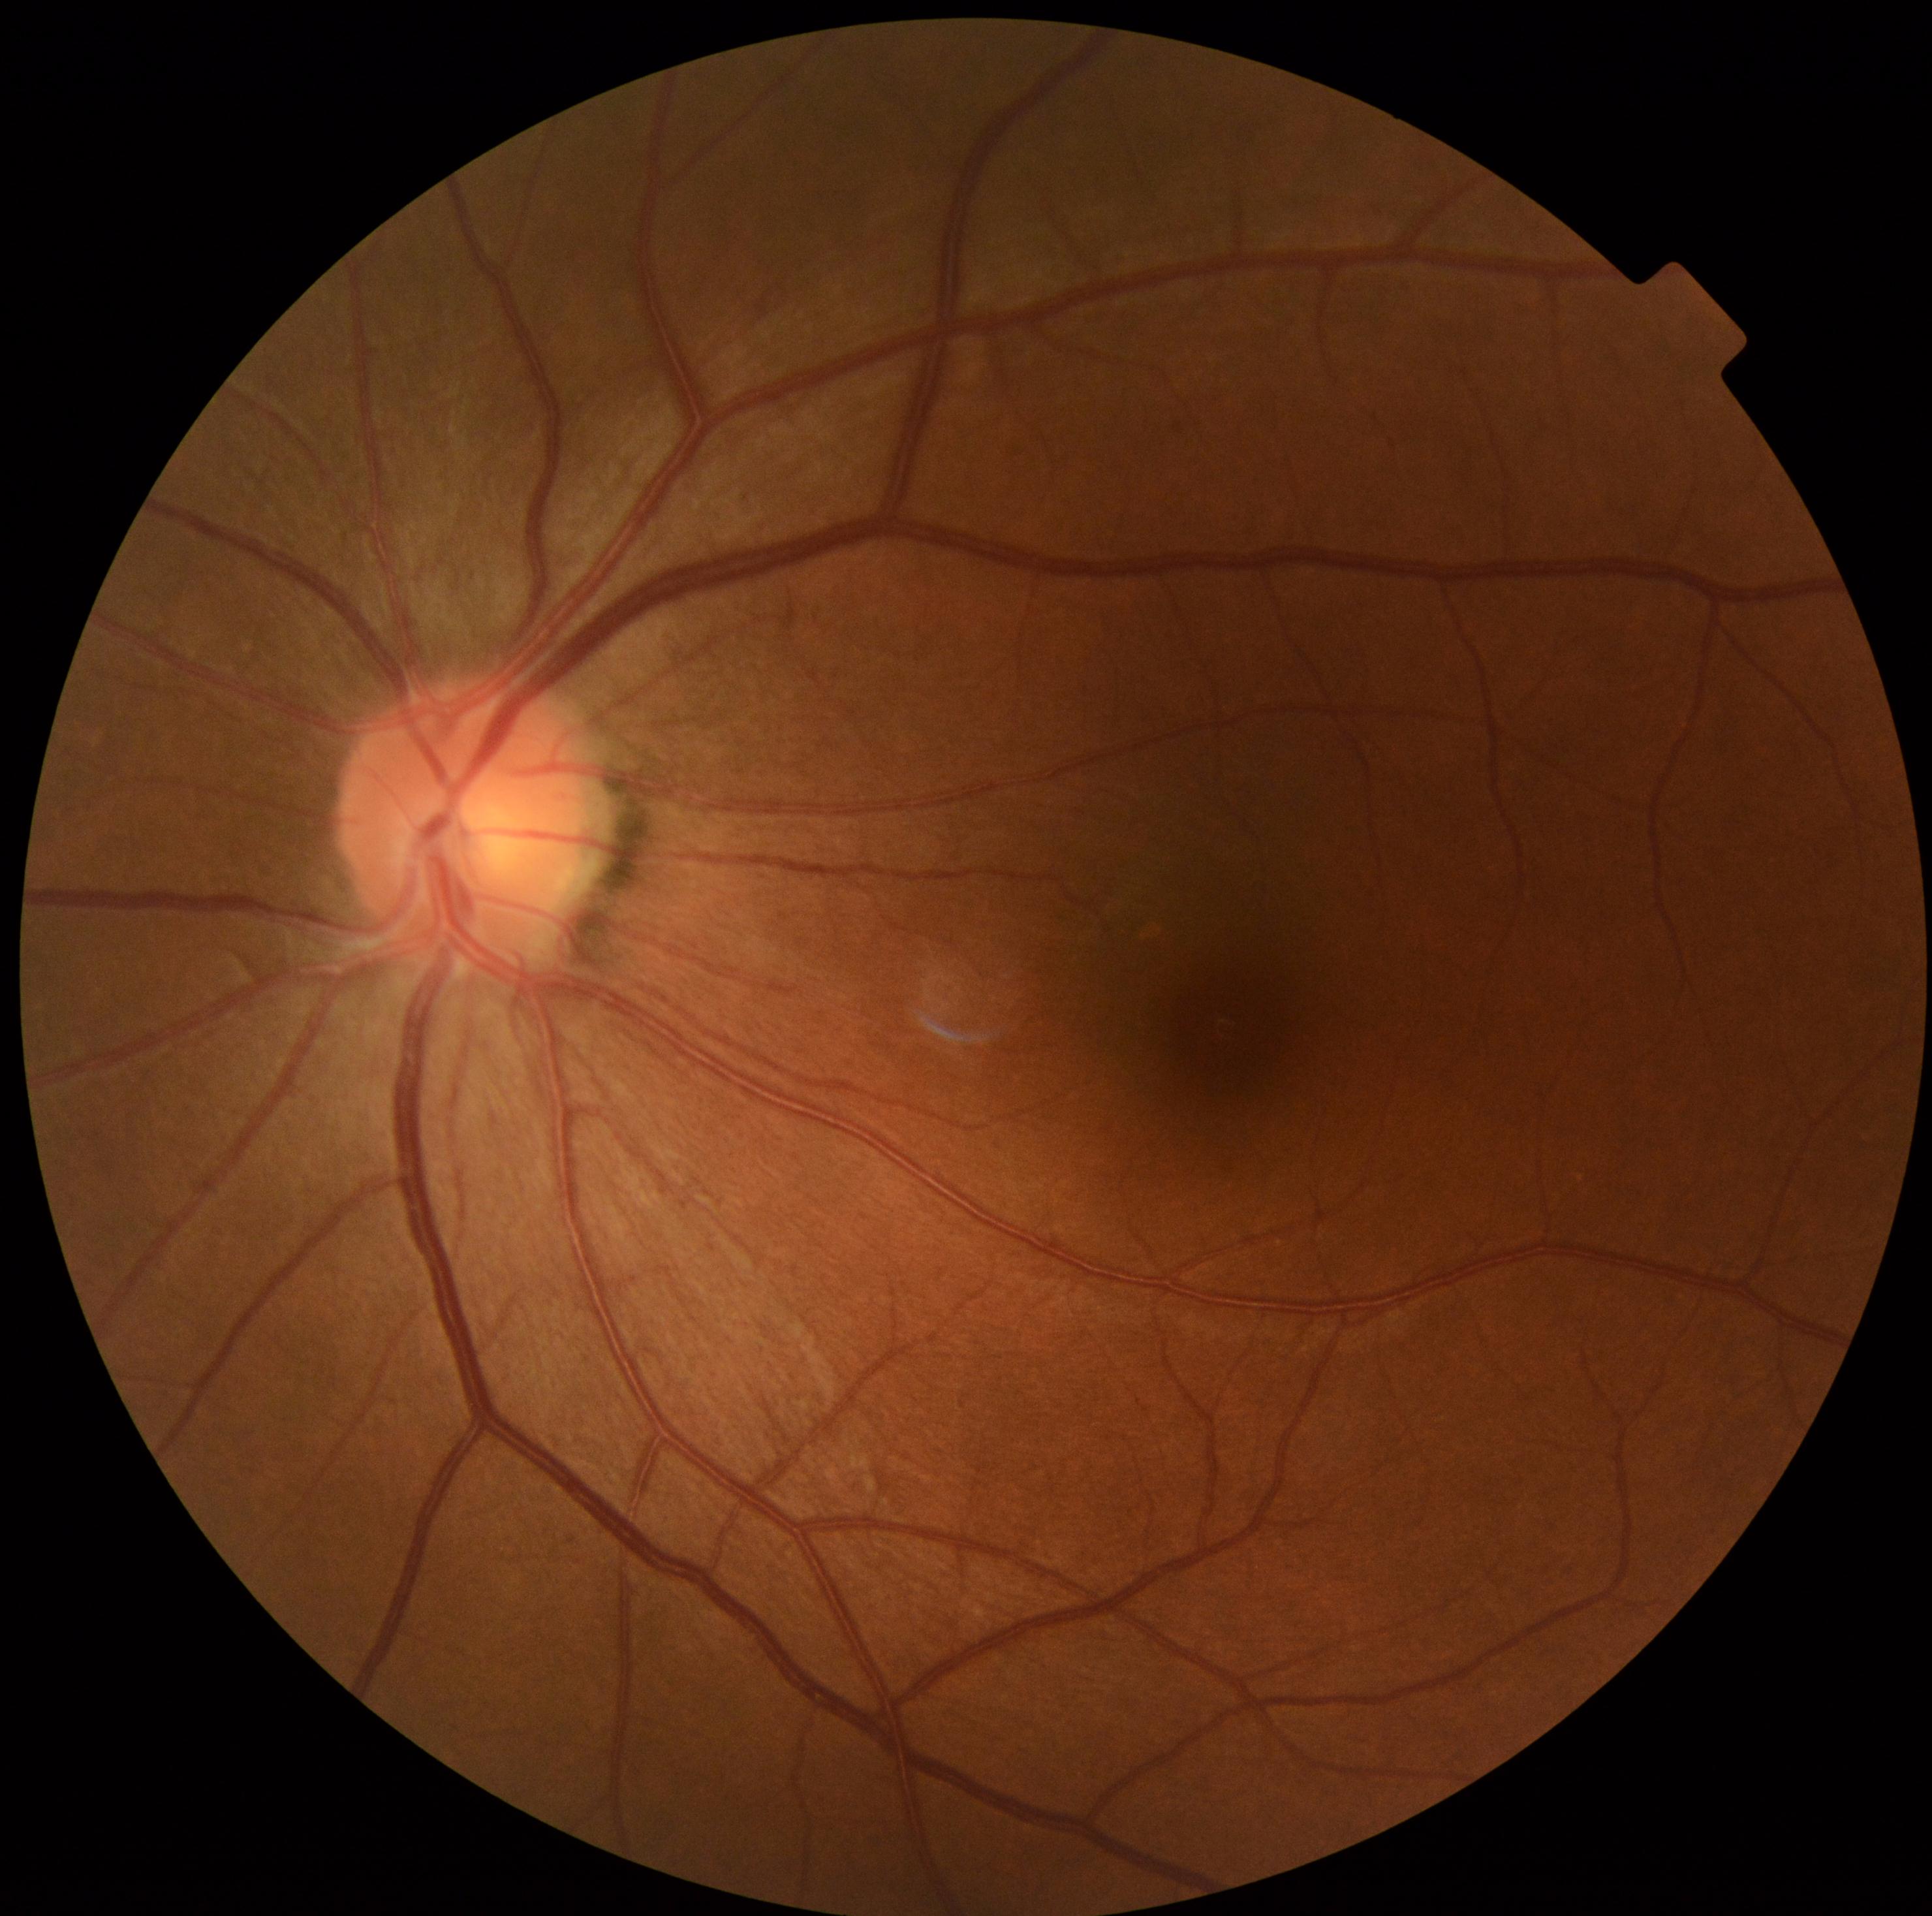

Diabetic retinopathy severity: grade 0 (no apparent retinopathy).